45-degree field of view; 848 by 848 pixels; acquired with a NIDEK AFC-230; nonmydriatic; retinal fundus photograph:
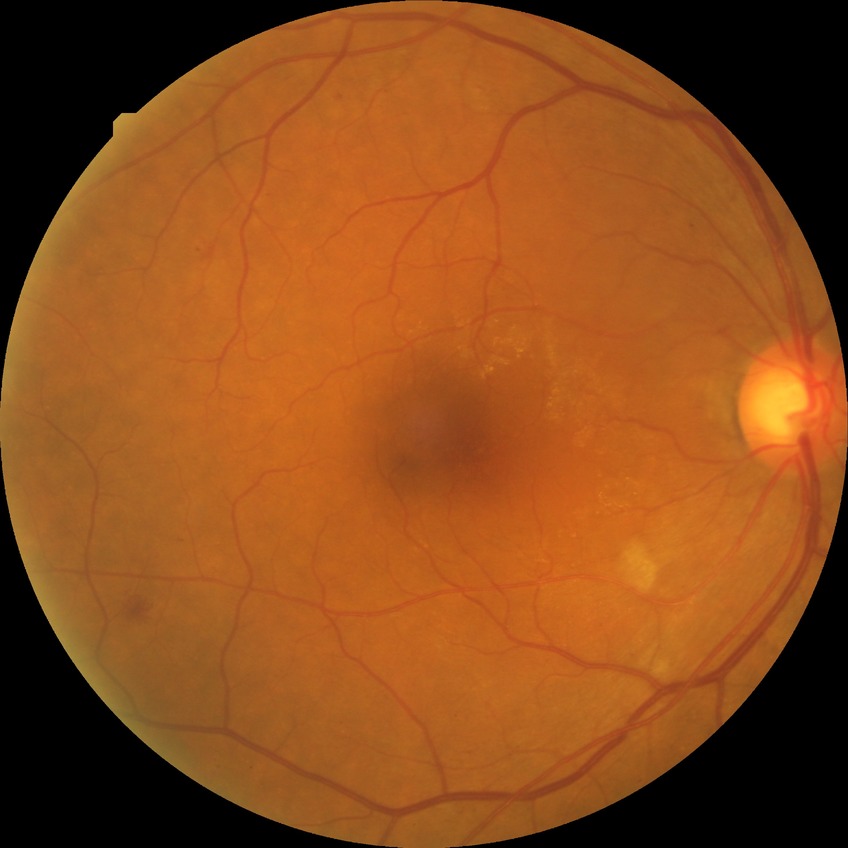 Diabetic retinopathy (DR) is PPDR (pre-proliferative diabetic retinopathy).